Nonmydriatic fundus photograph. Modified Davis classification. 848 by 848 pixels:
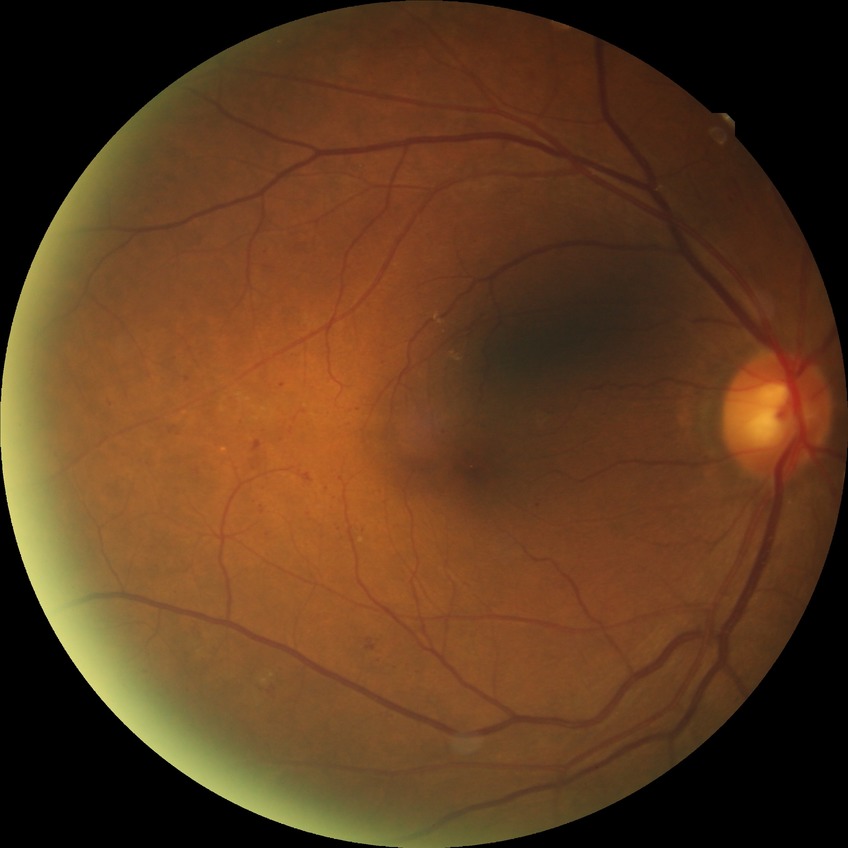

diabetic retinopathy (DR) = SDR (simple diabetic retinopathy).